Image size 1932x1932. Retinal fundus photograph. 45° FOV — 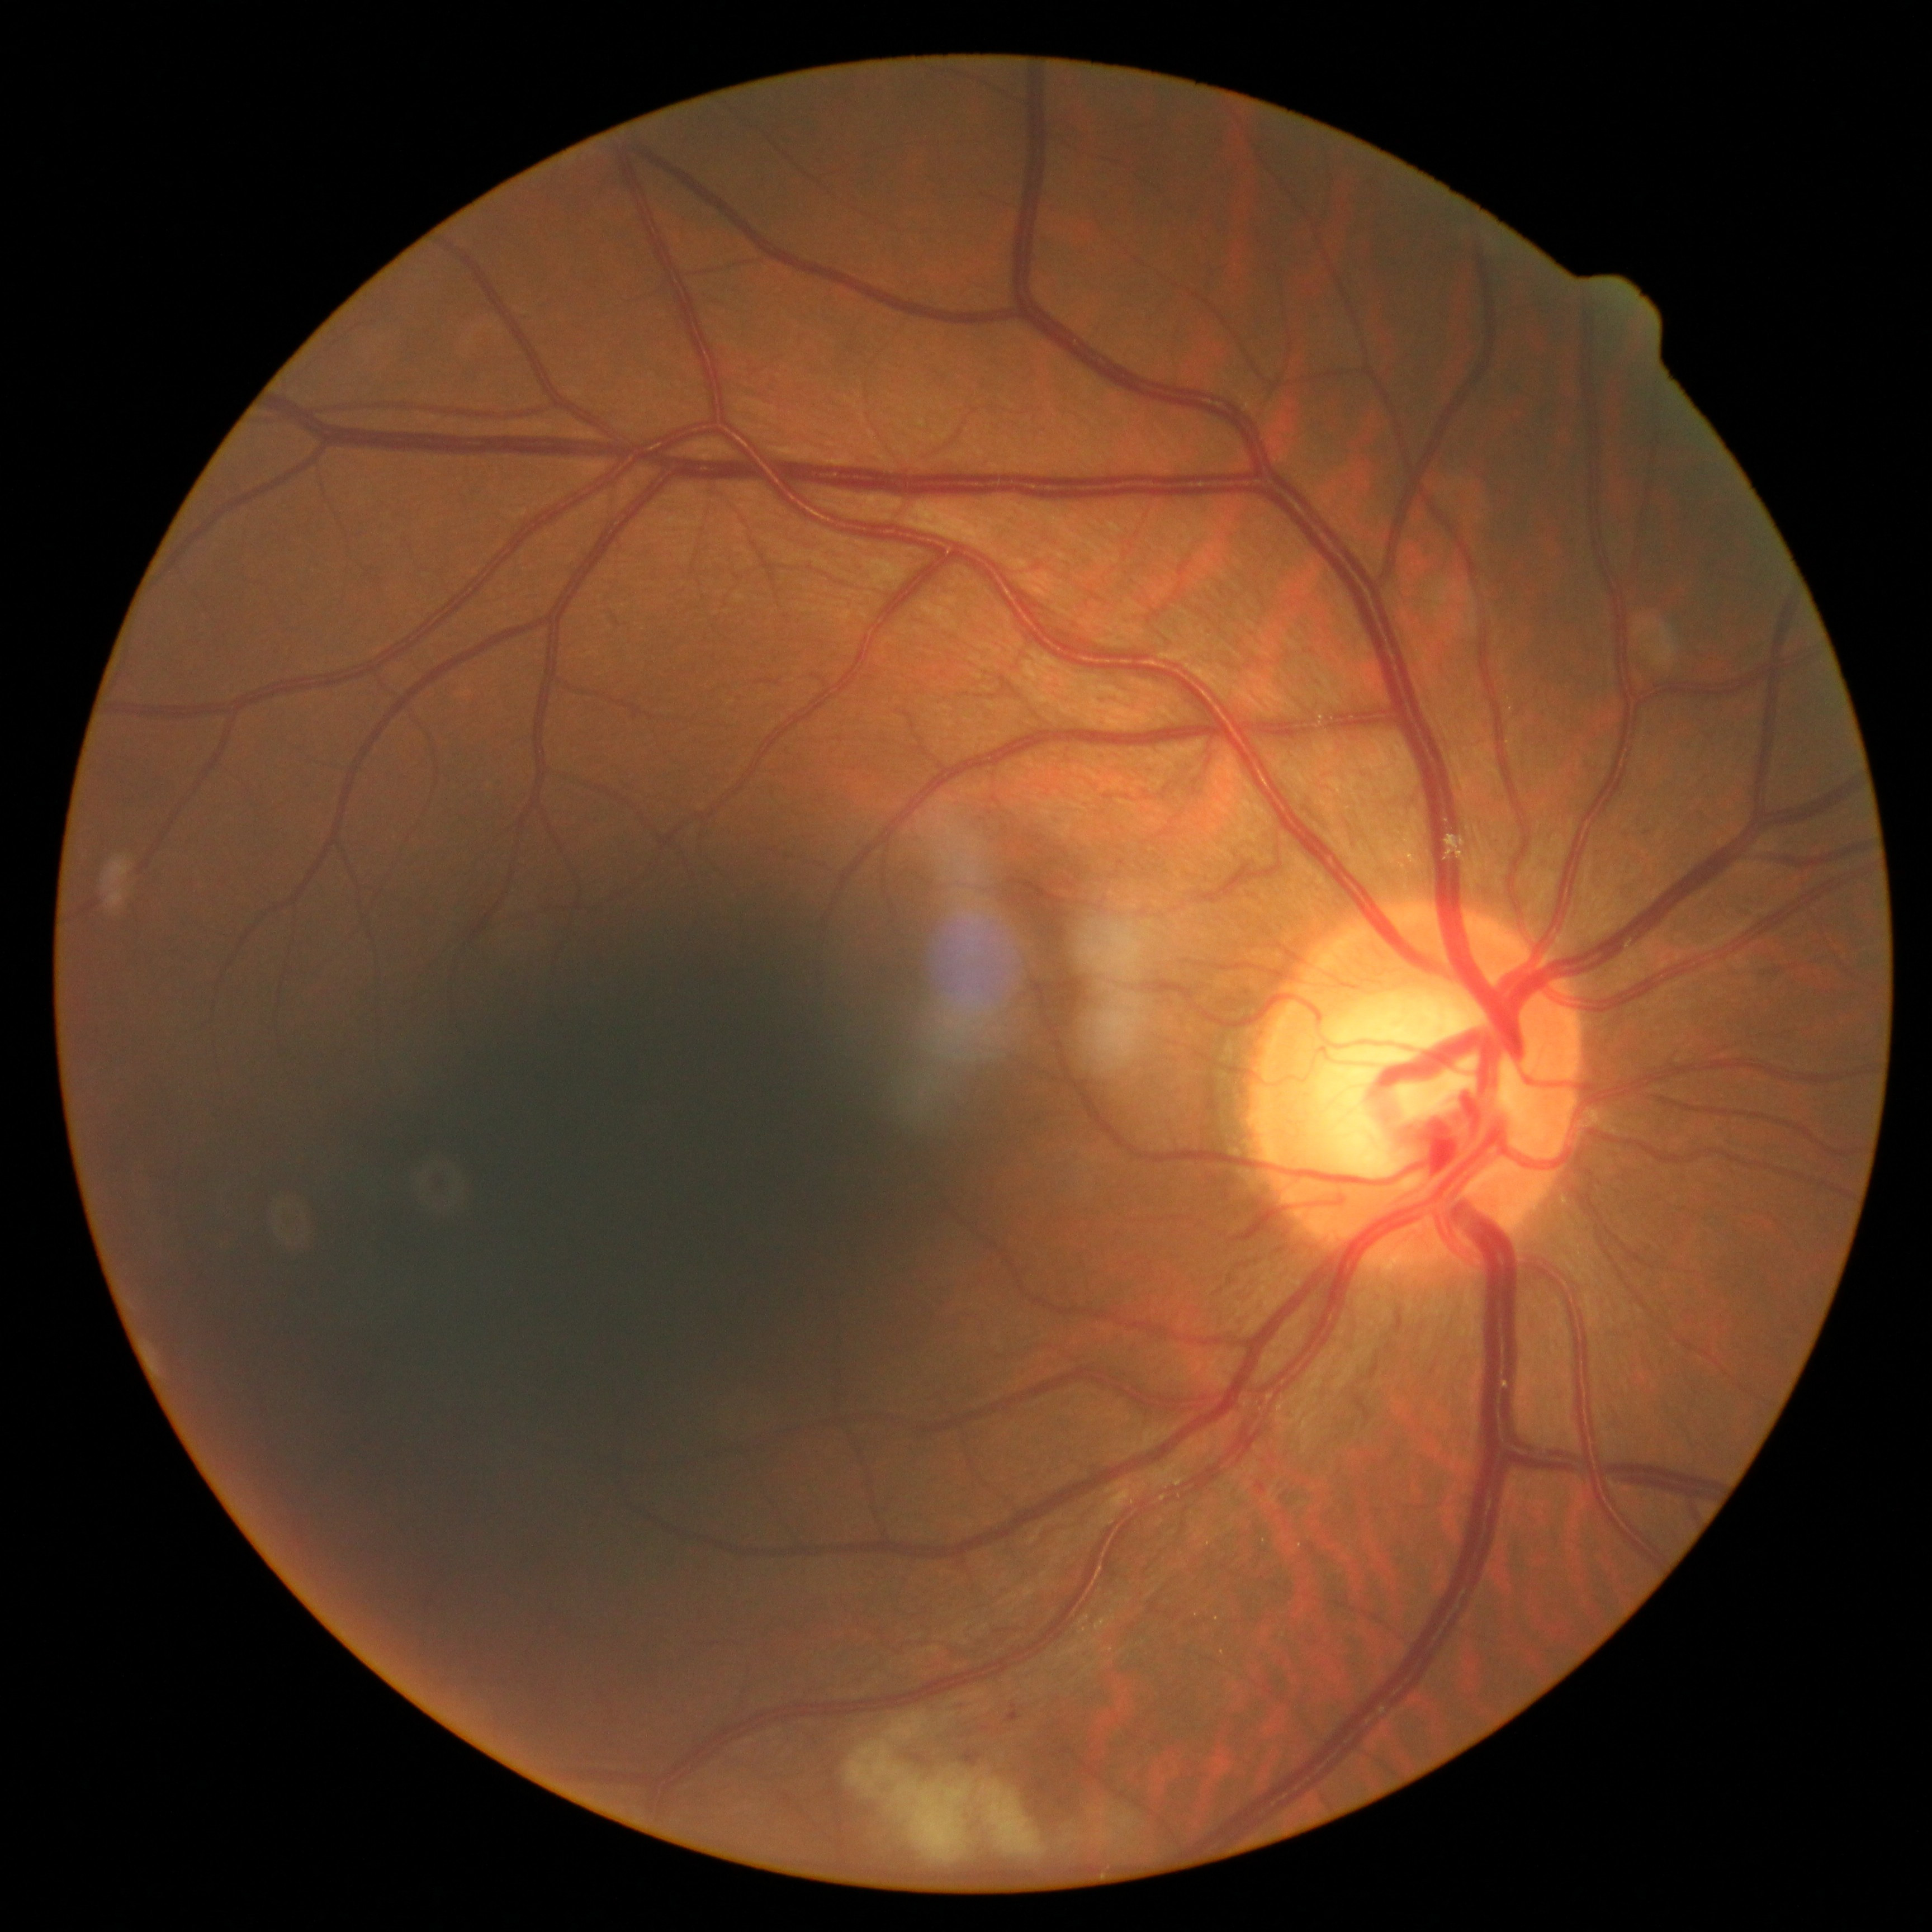
Diabetic retinopathy (DR) is moderate non-proliferative diabetic retinopathy (grade 2).